Color fundus photograph: 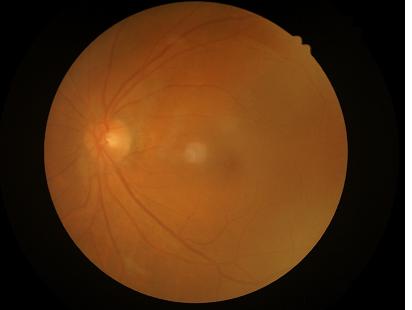
{"clarity": "poor", "contrast": "adequate", "illumination": "satisfactory", "overall_quality": "poor"}